Modified Davis grading; 45° field of view — 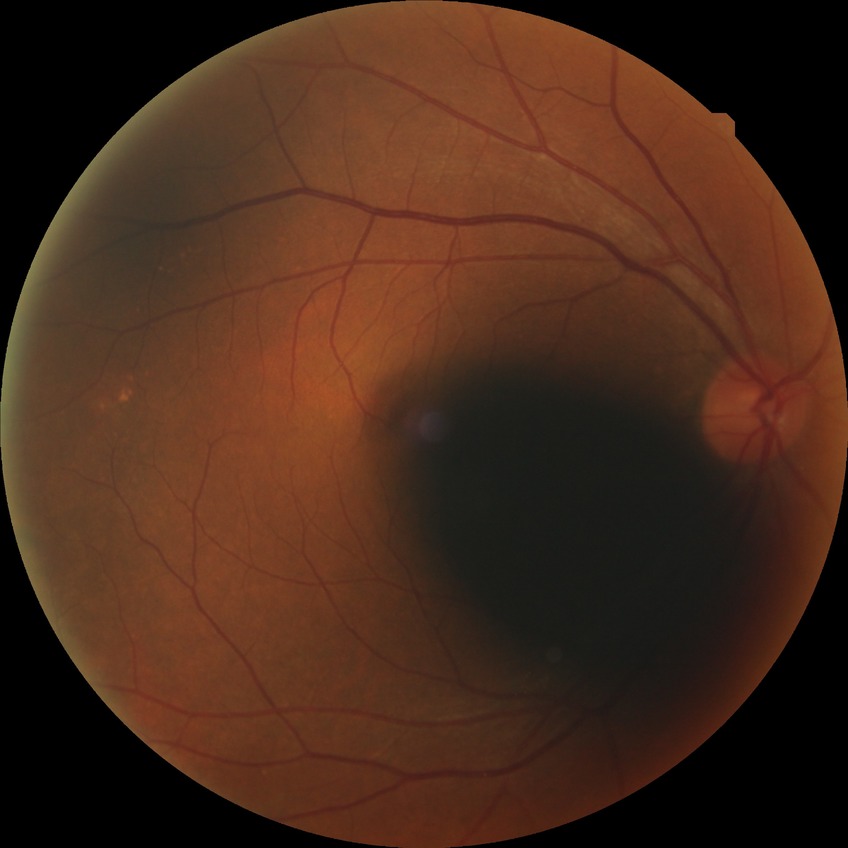 modified Davis classification: no diabetic retinopathy.